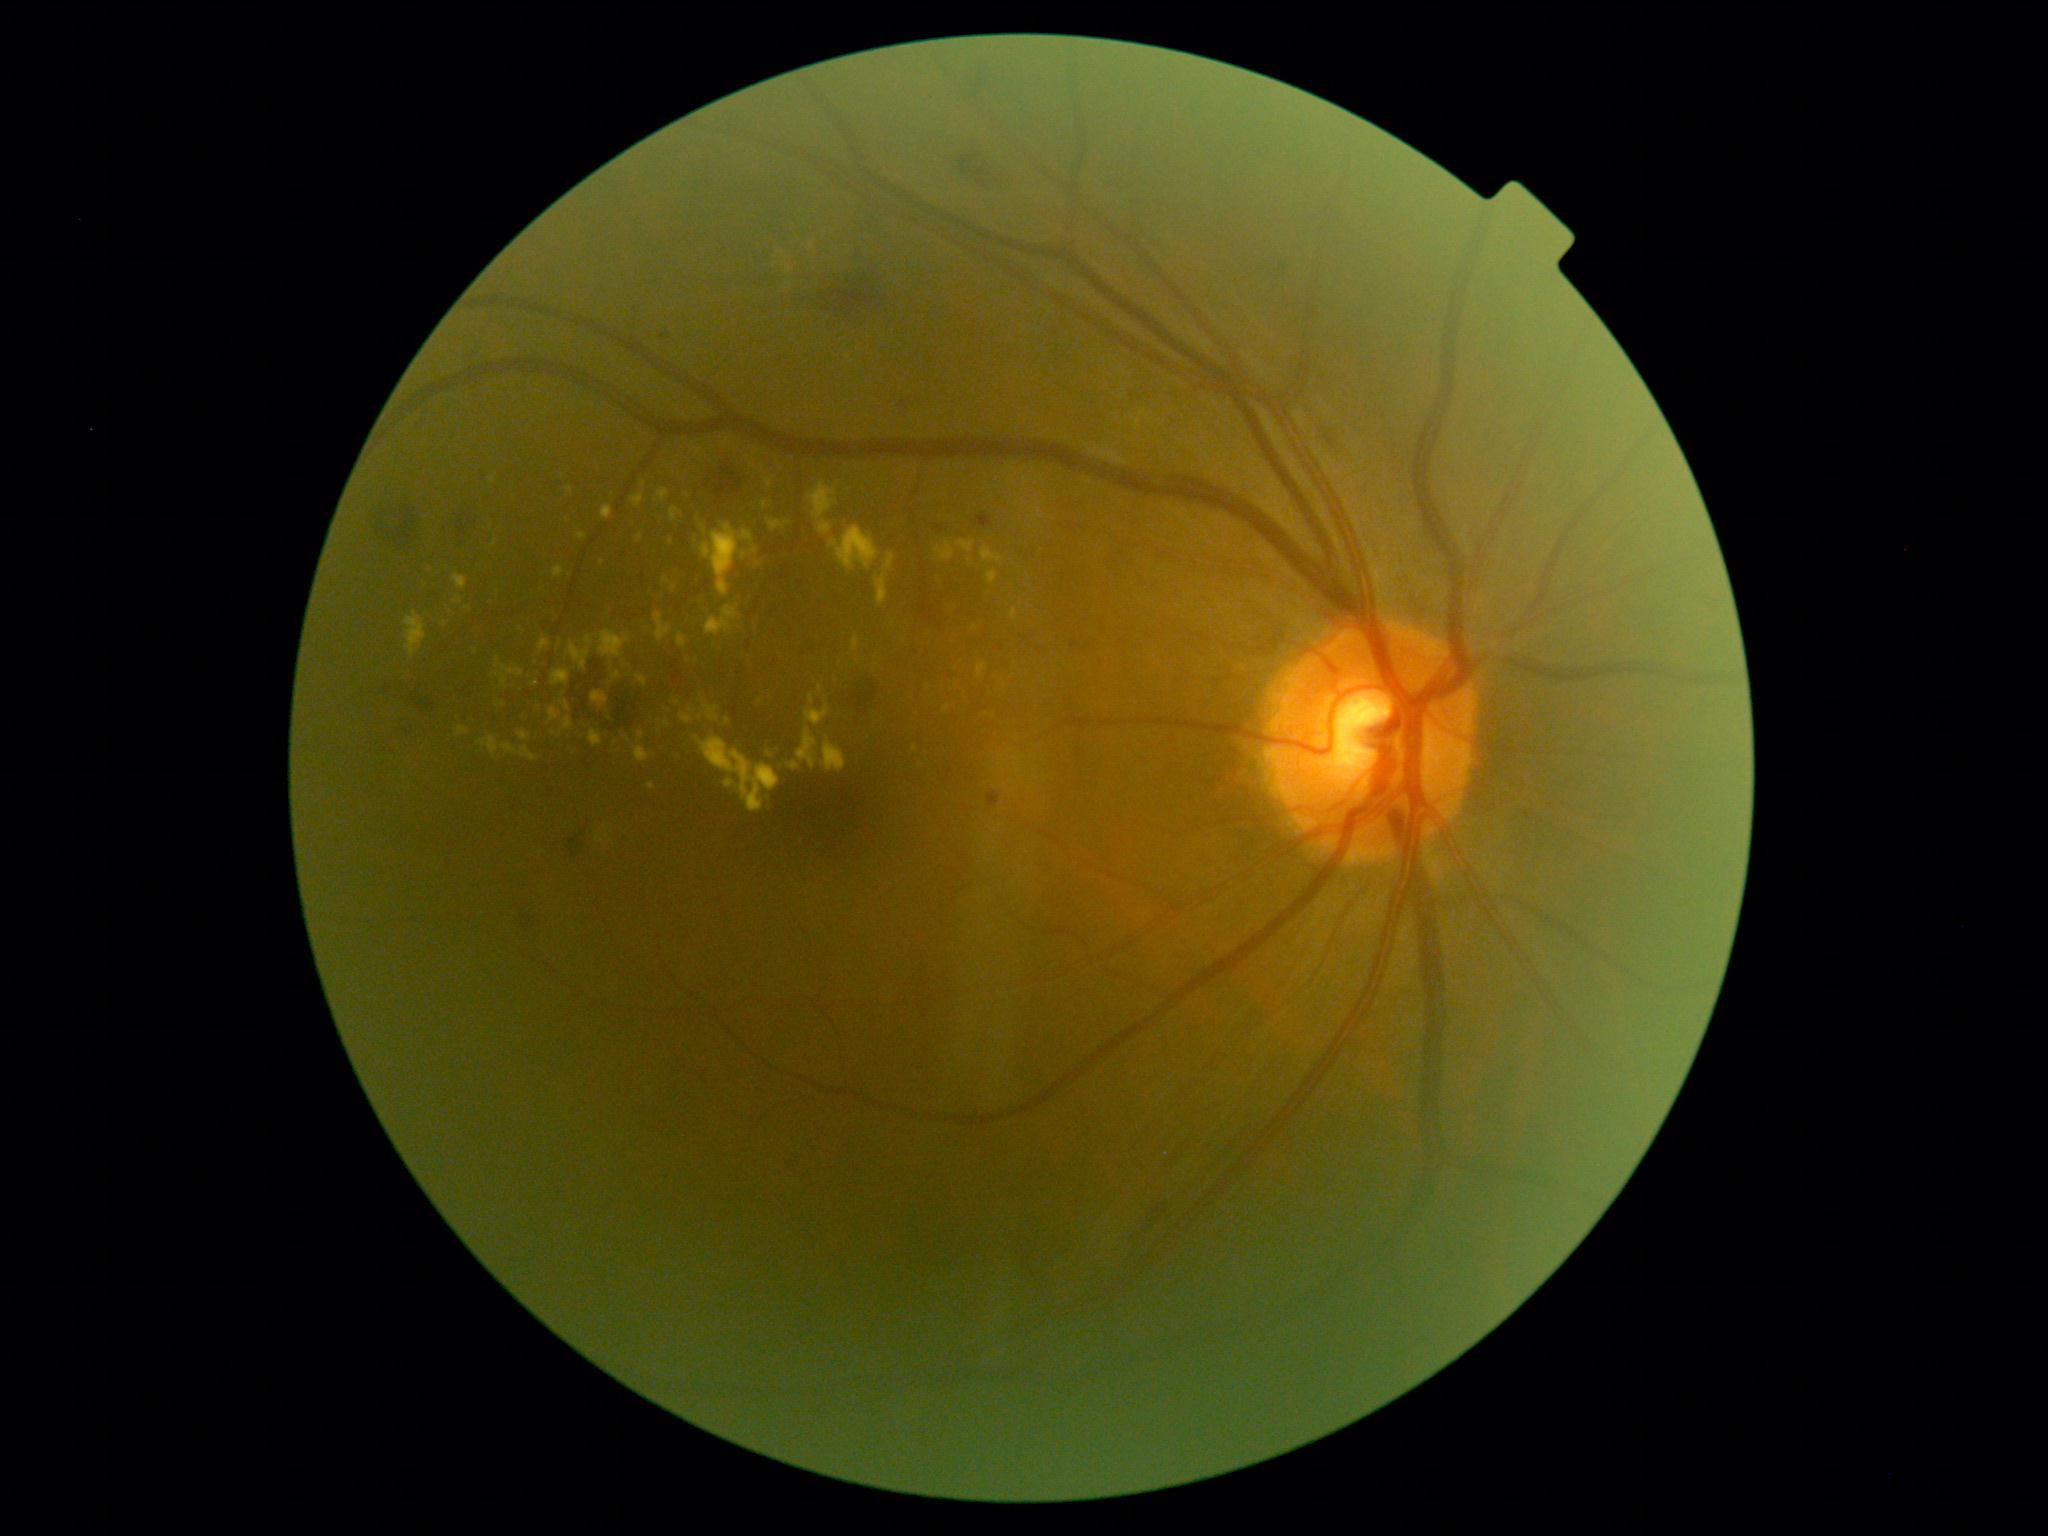
DR grade: 2 — more than just microaneurysms but less than severe NPDR
Selected lesions:
- EXs (more not shown): region(701, 524, 708, 535); region(956, 541, 976, 554); region(982, 546, 1005, 565); region(874, 554, 896, 607); region(810, 696, 814, 704); region(560, 717, 574, 733); region(602, 506, 613, 521); region(494, 658, 524, 688); region(648, 783, 656, 790); region(658, 489, 669, 502); region(457, 727, 470, 737)
- Additional small EXs near [x=921, y=765]; [x=1036, y=778]; [x=761, y=701]; [x=493, y=481]; [x=689, y=661]; [x=476, y=652]